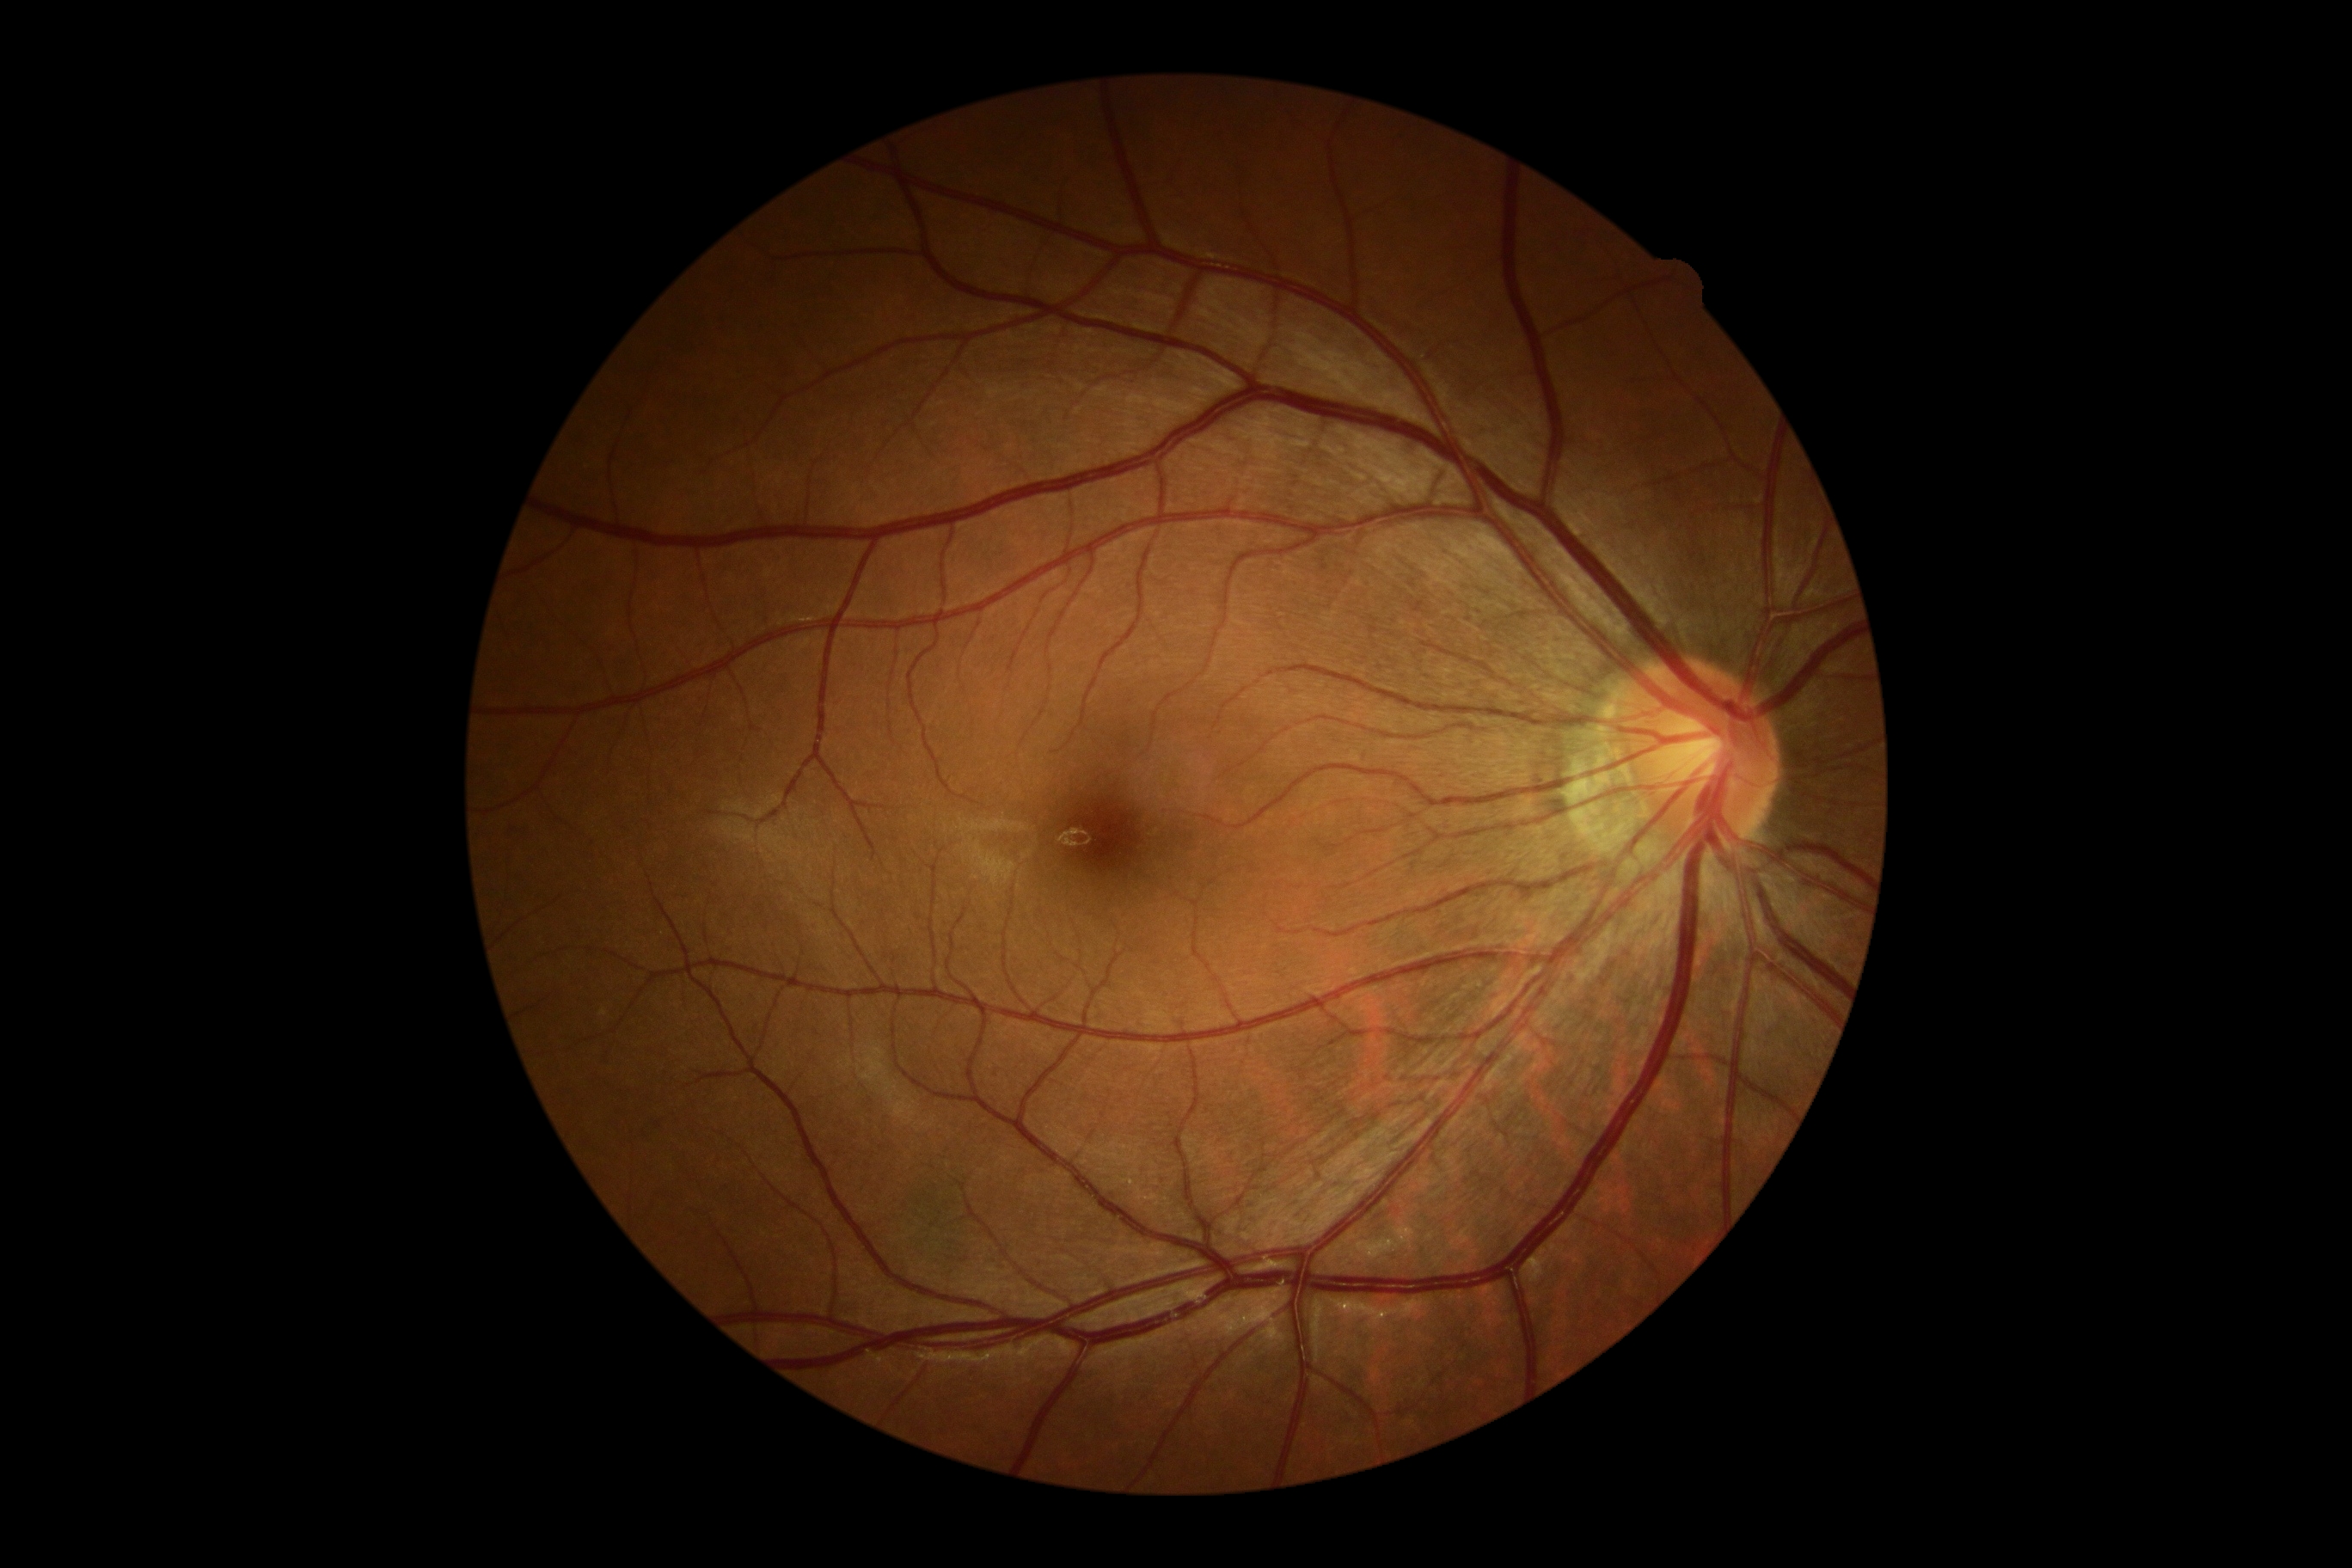

Diabetic retinopathy severity is grade 0. No DR findings.